Posterior pole color fundus photograph: 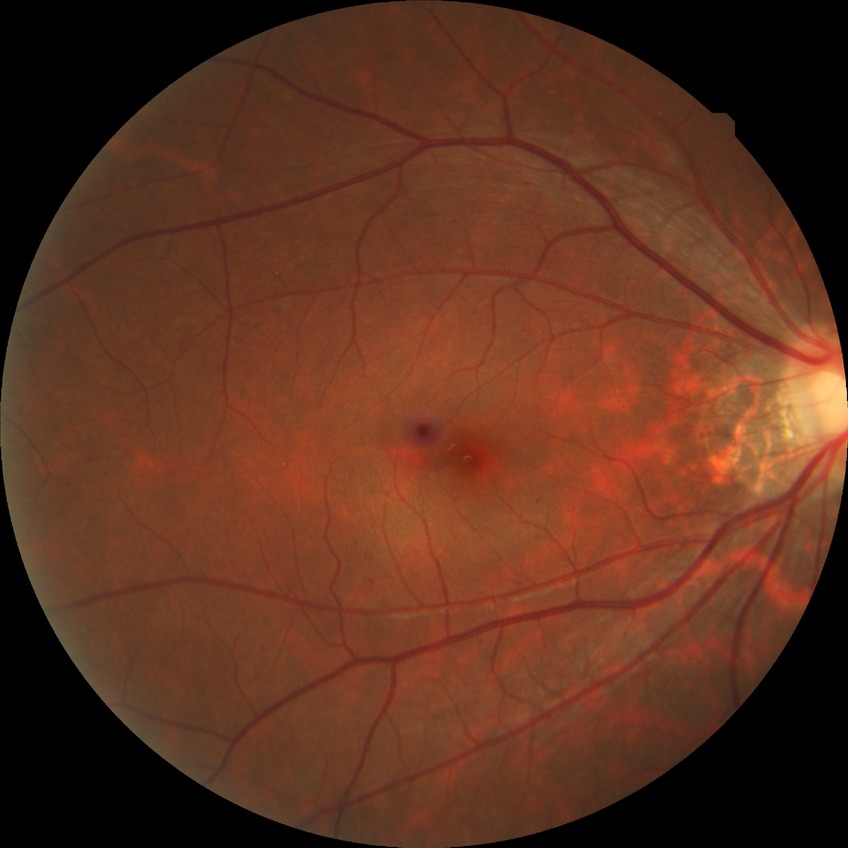

Retinopathy stage: simple diabetic retinopathy.